Pediatric wide-field fundus photograph — 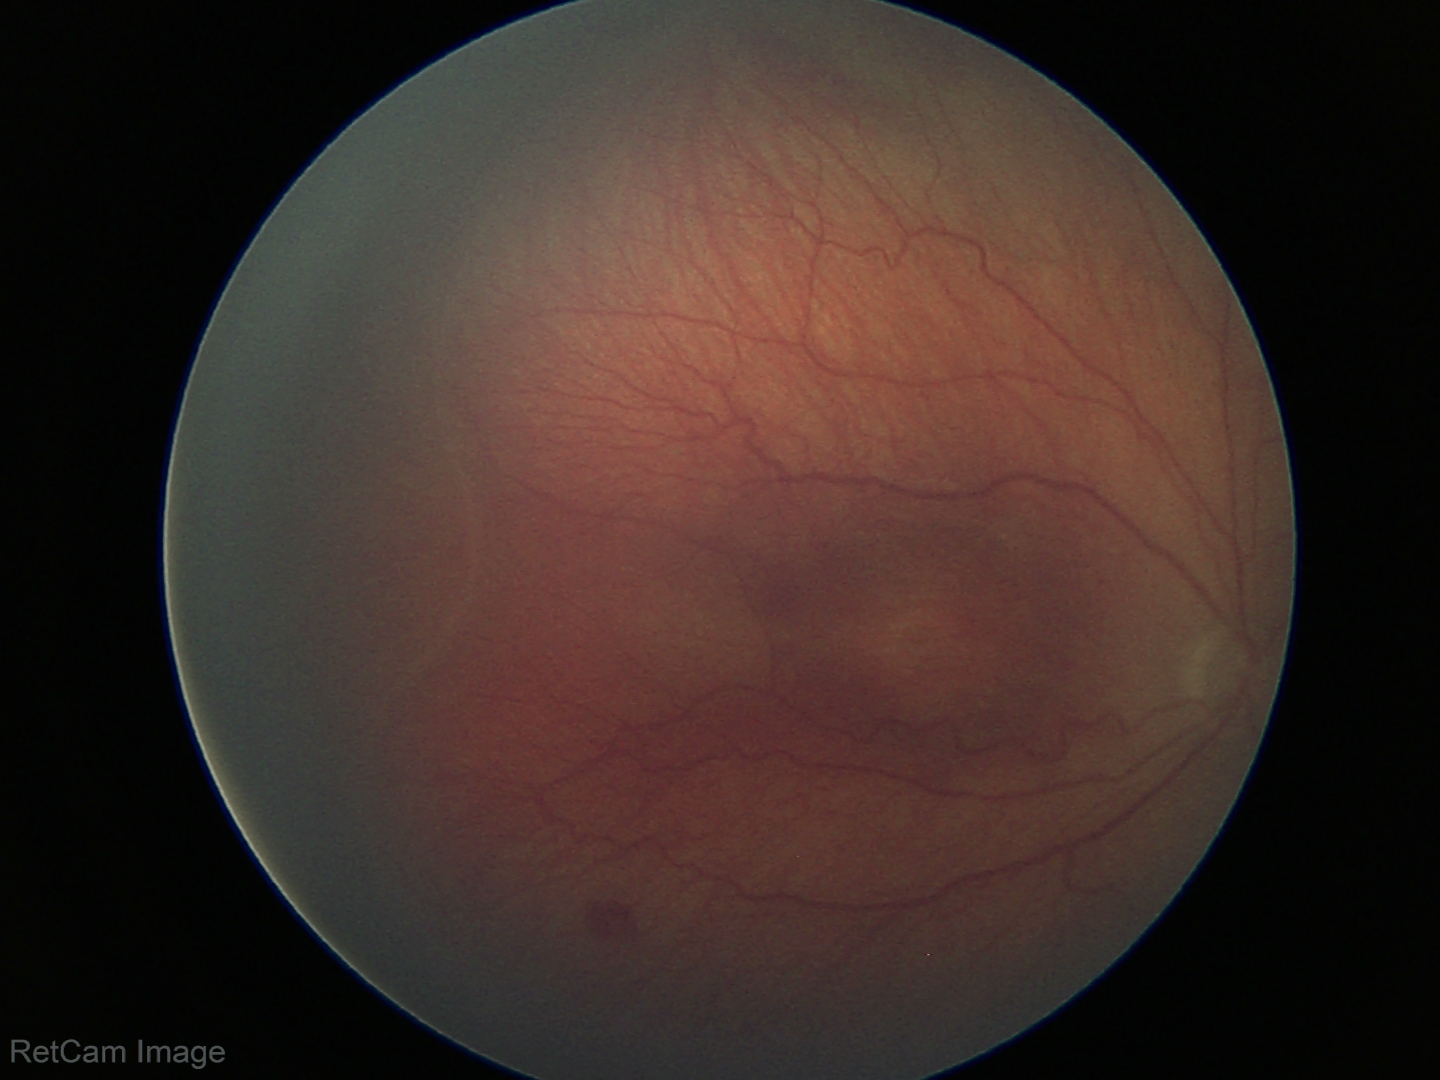 Q: What was the screening finding?
A: retinopathy of prematurity (ROP) stage 3 — ridge with extraretinal fibrovascular proliferation